No pharmacologic dilation, 45-degree field of view, image size 848x848, Davis DR grading.
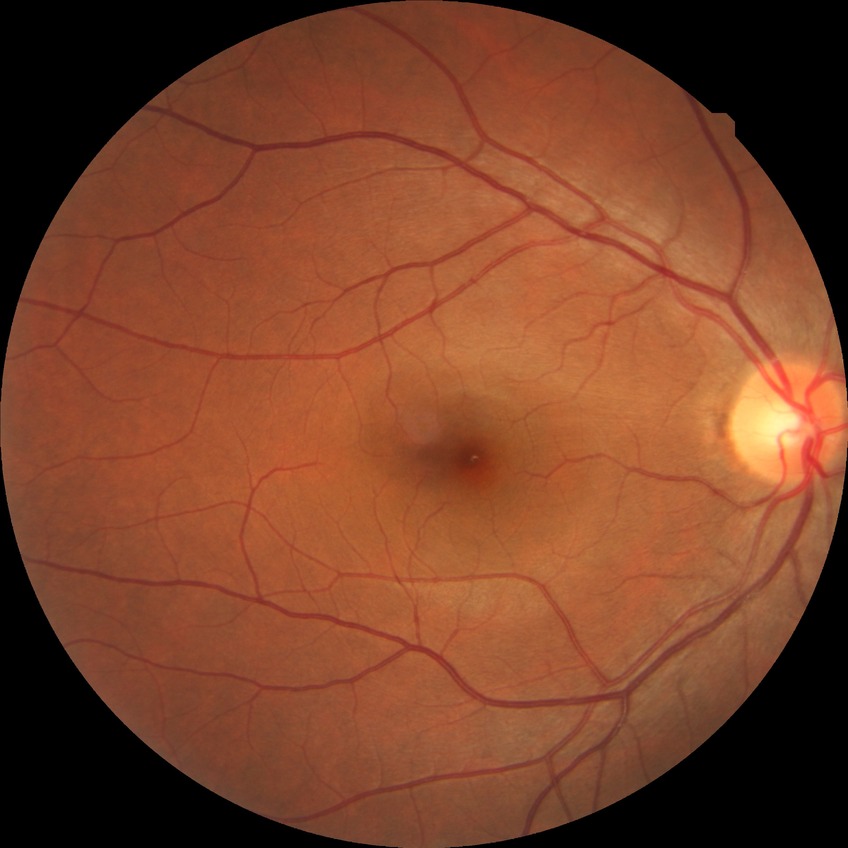

davis_grade: no diabetic retinopathy (NDR)